45° field of view · modified Davis grading · fundus photo: 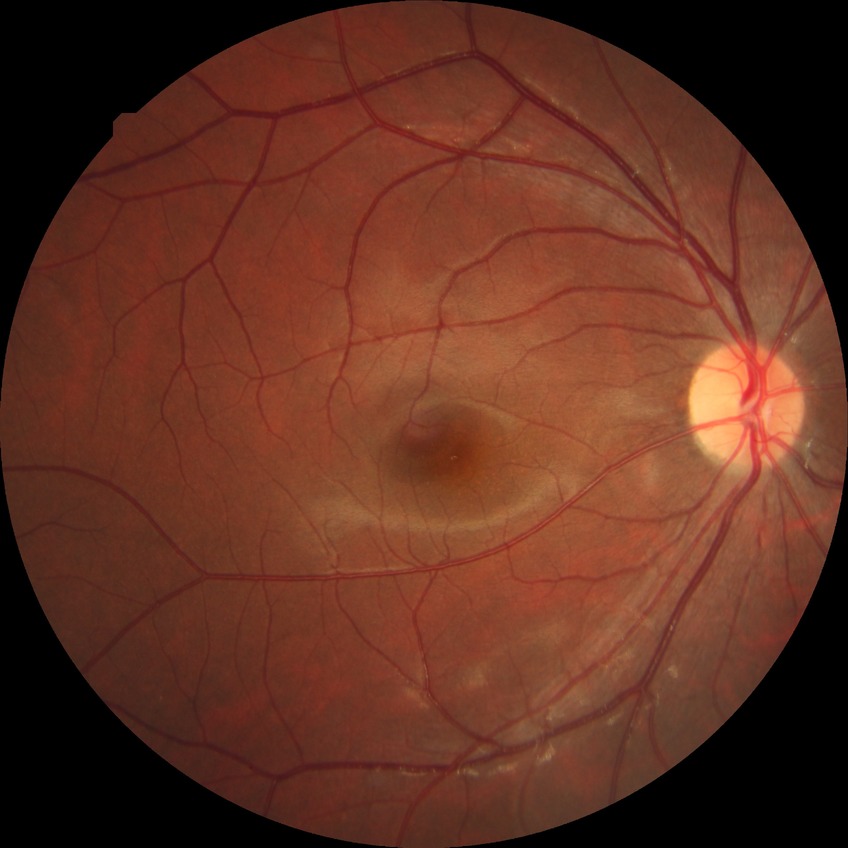

Diabetic retinopathy (DR): no diabetic retinopathy (NDR).